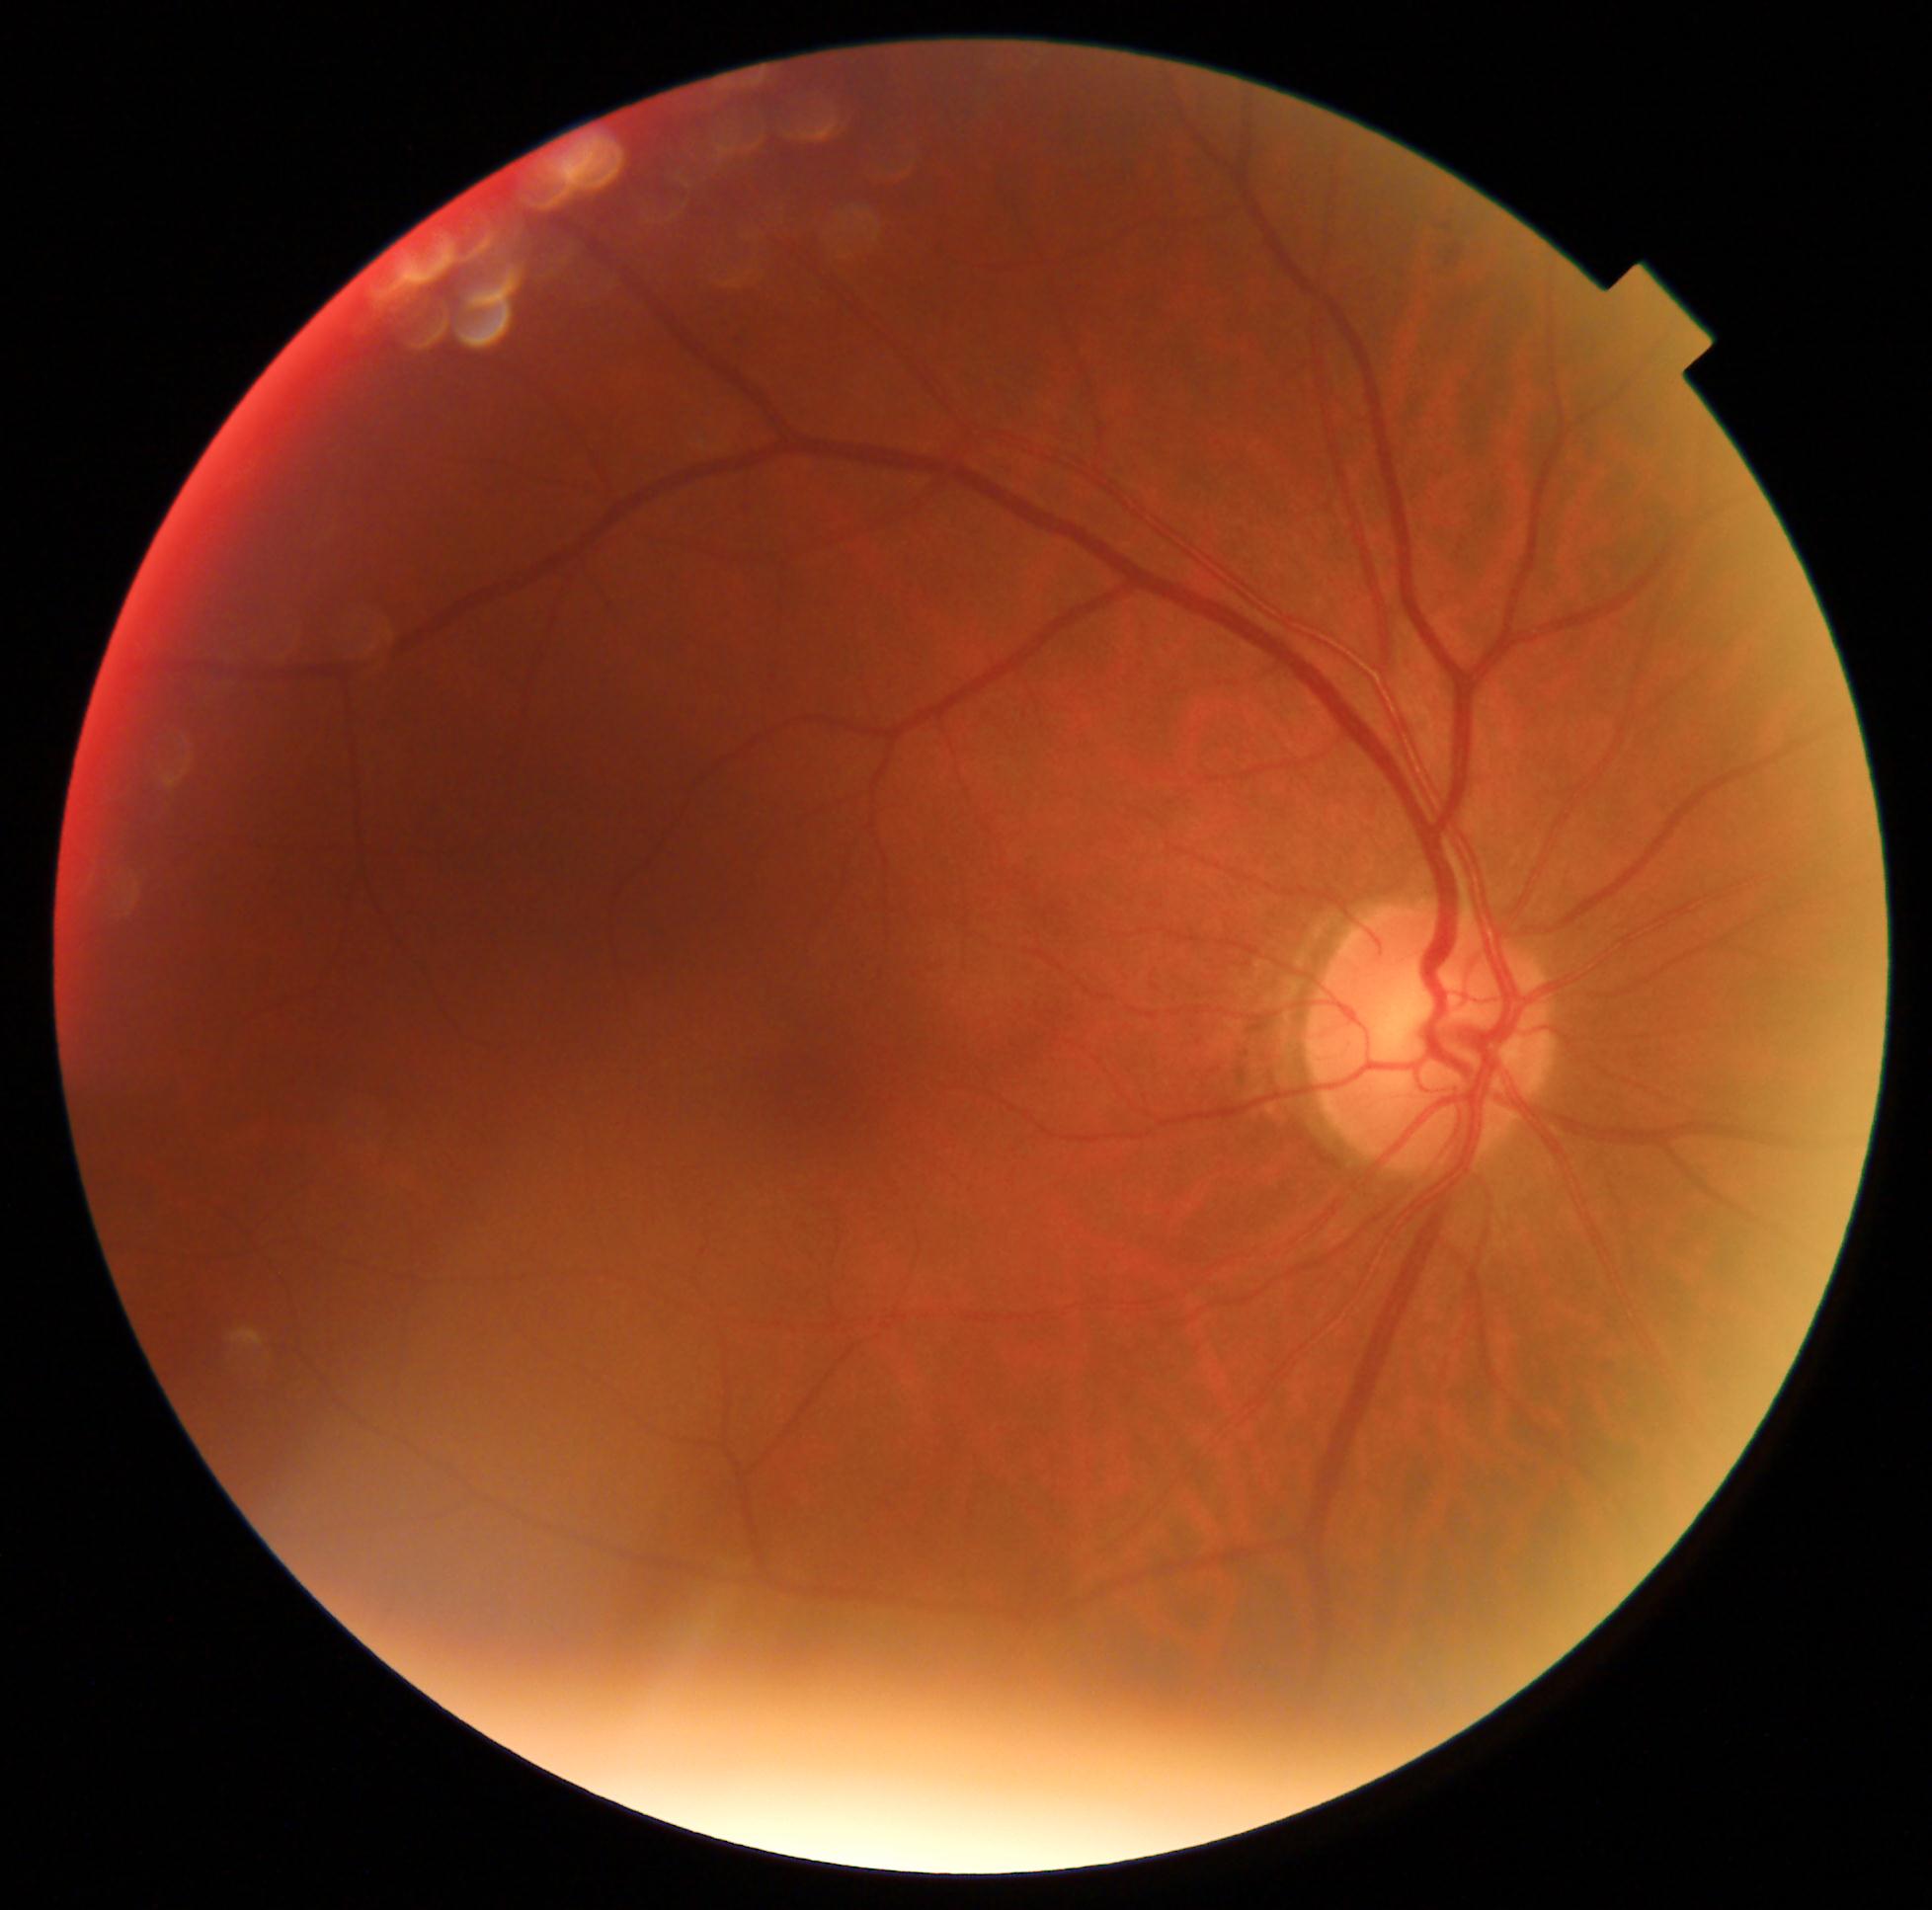
diabetic retinopathy severity: 0 | DR impression: negative for DR.